CFP · 2352x1568: 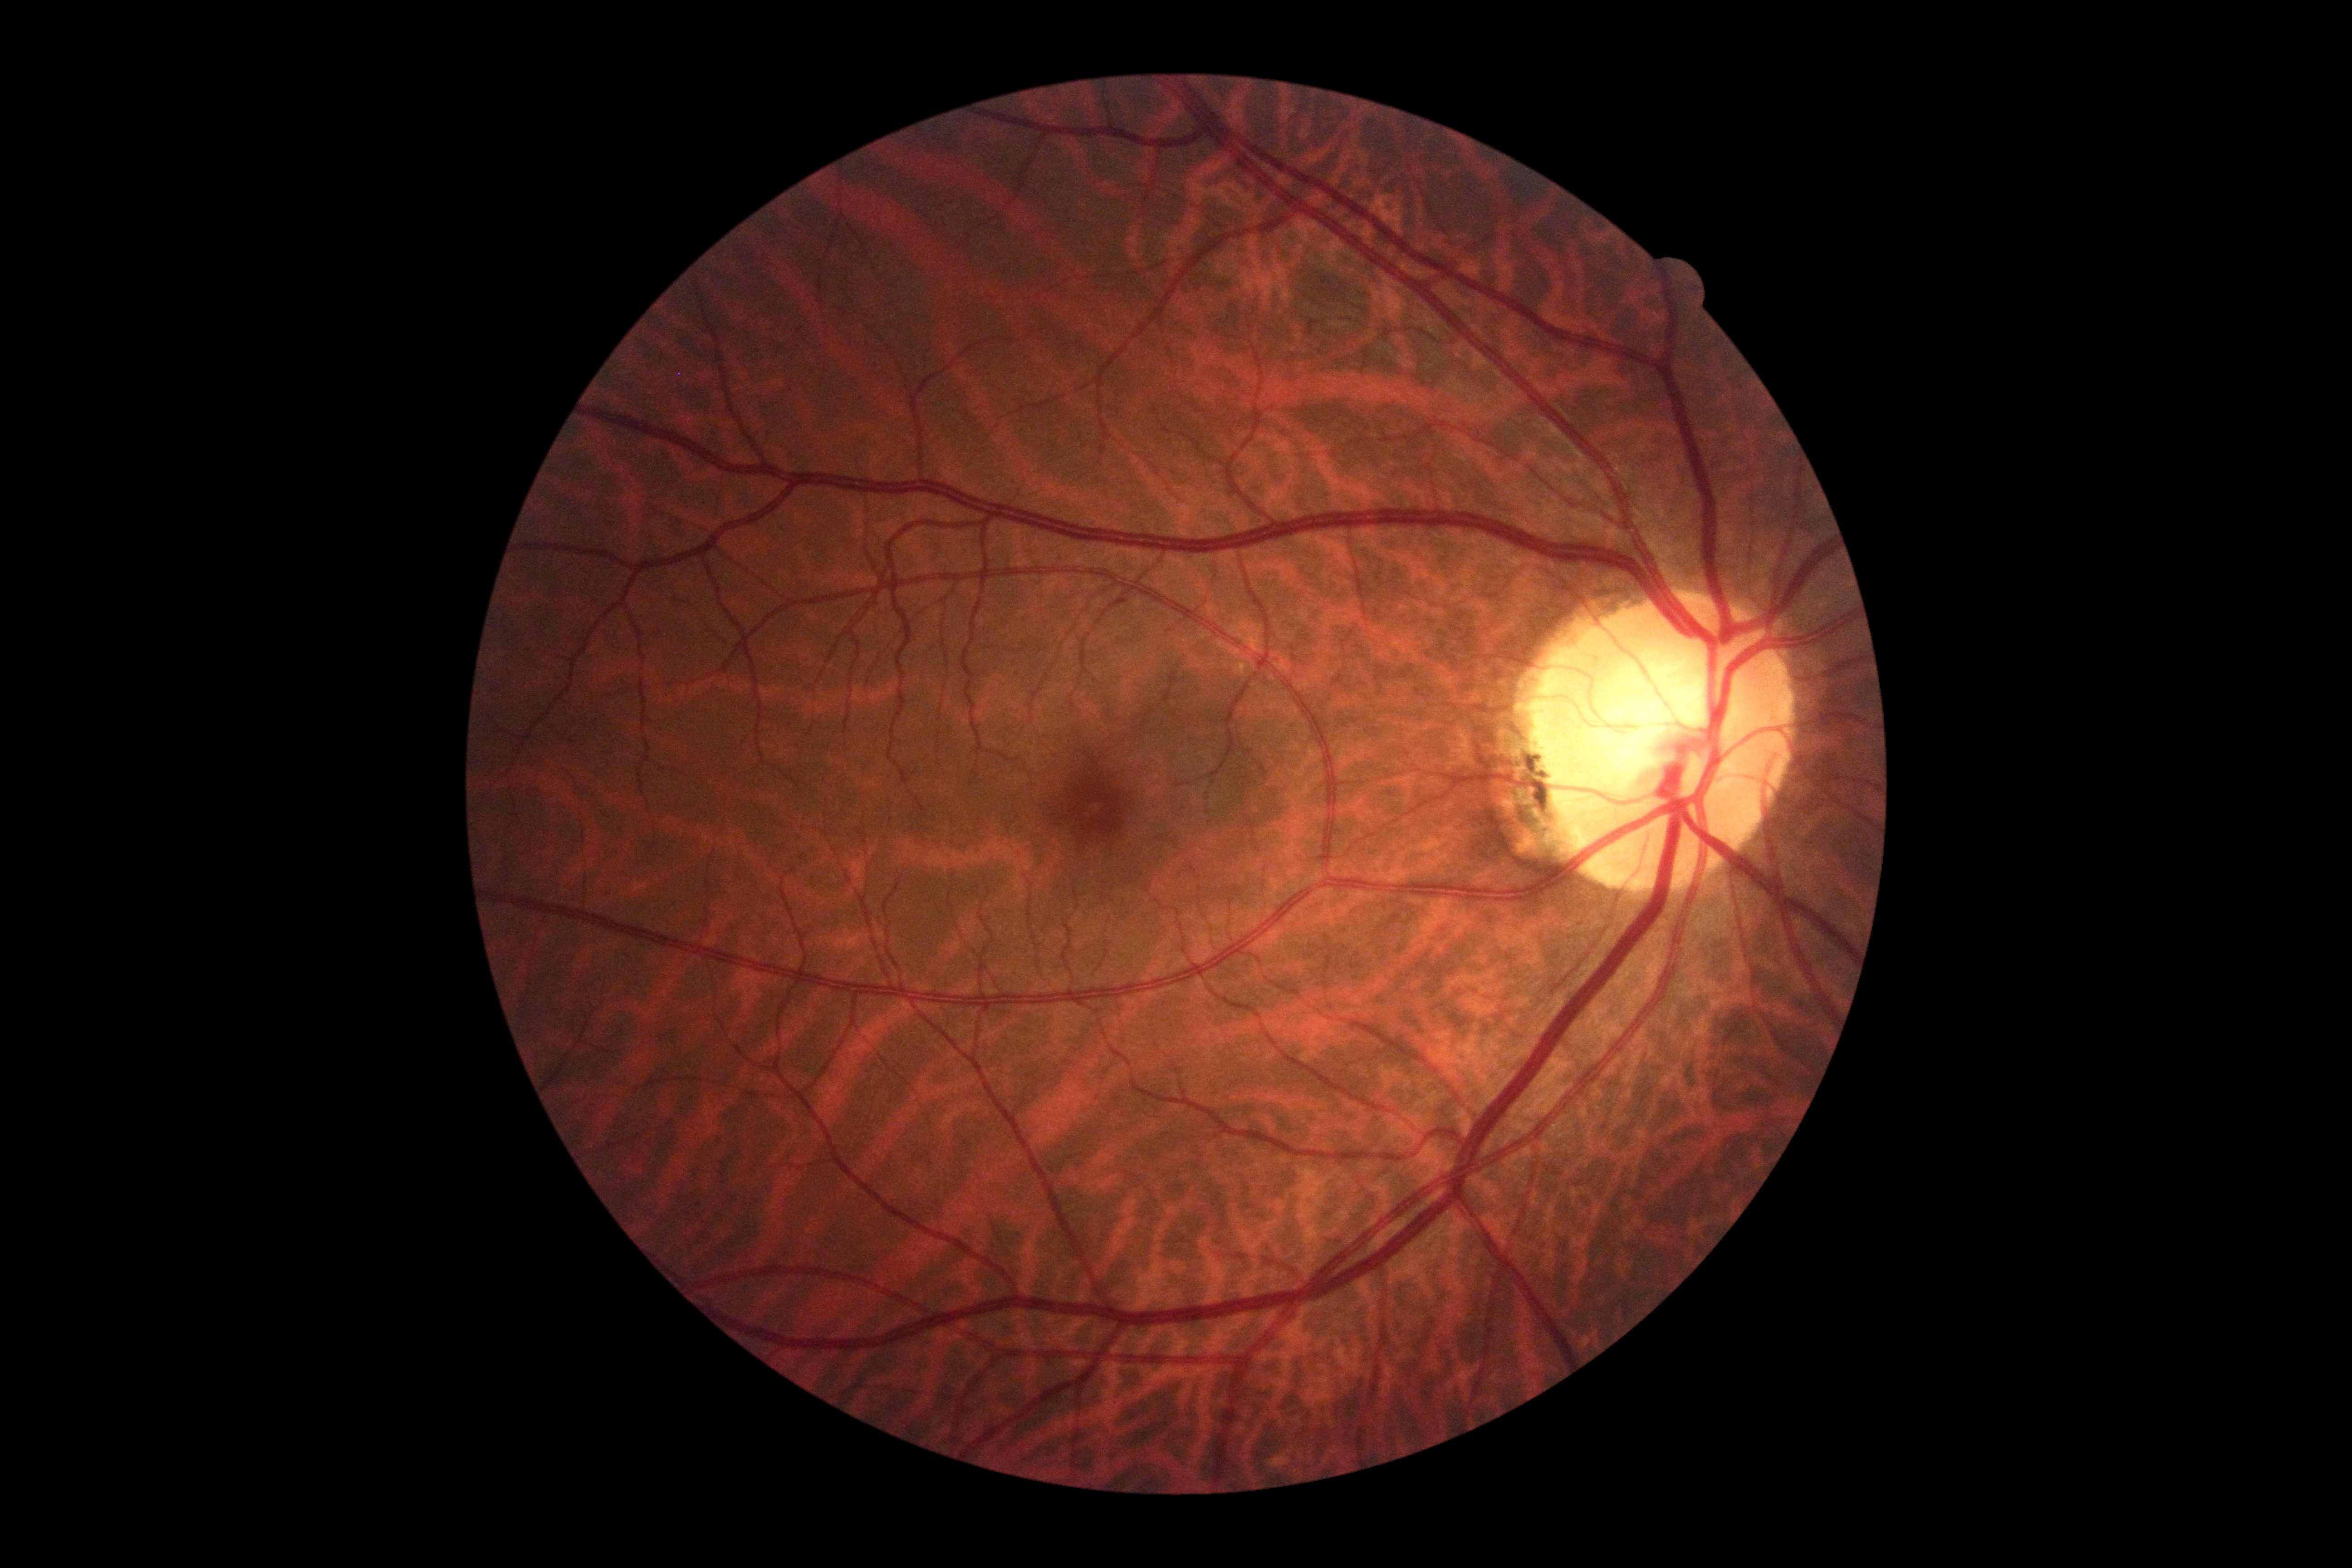

DR: no apparent retinopathy (grade 0).